Nonmydriatic, 45 degree fundus photograph — 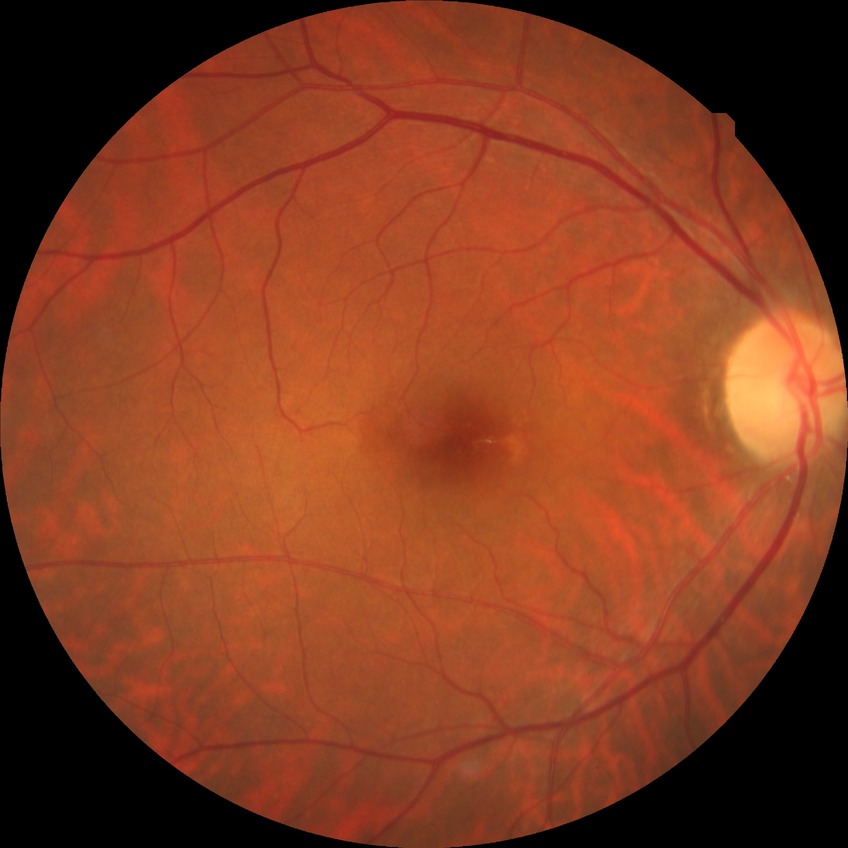
Diabetic retinopathy (DR): NDR (no diabetic retinopathy).